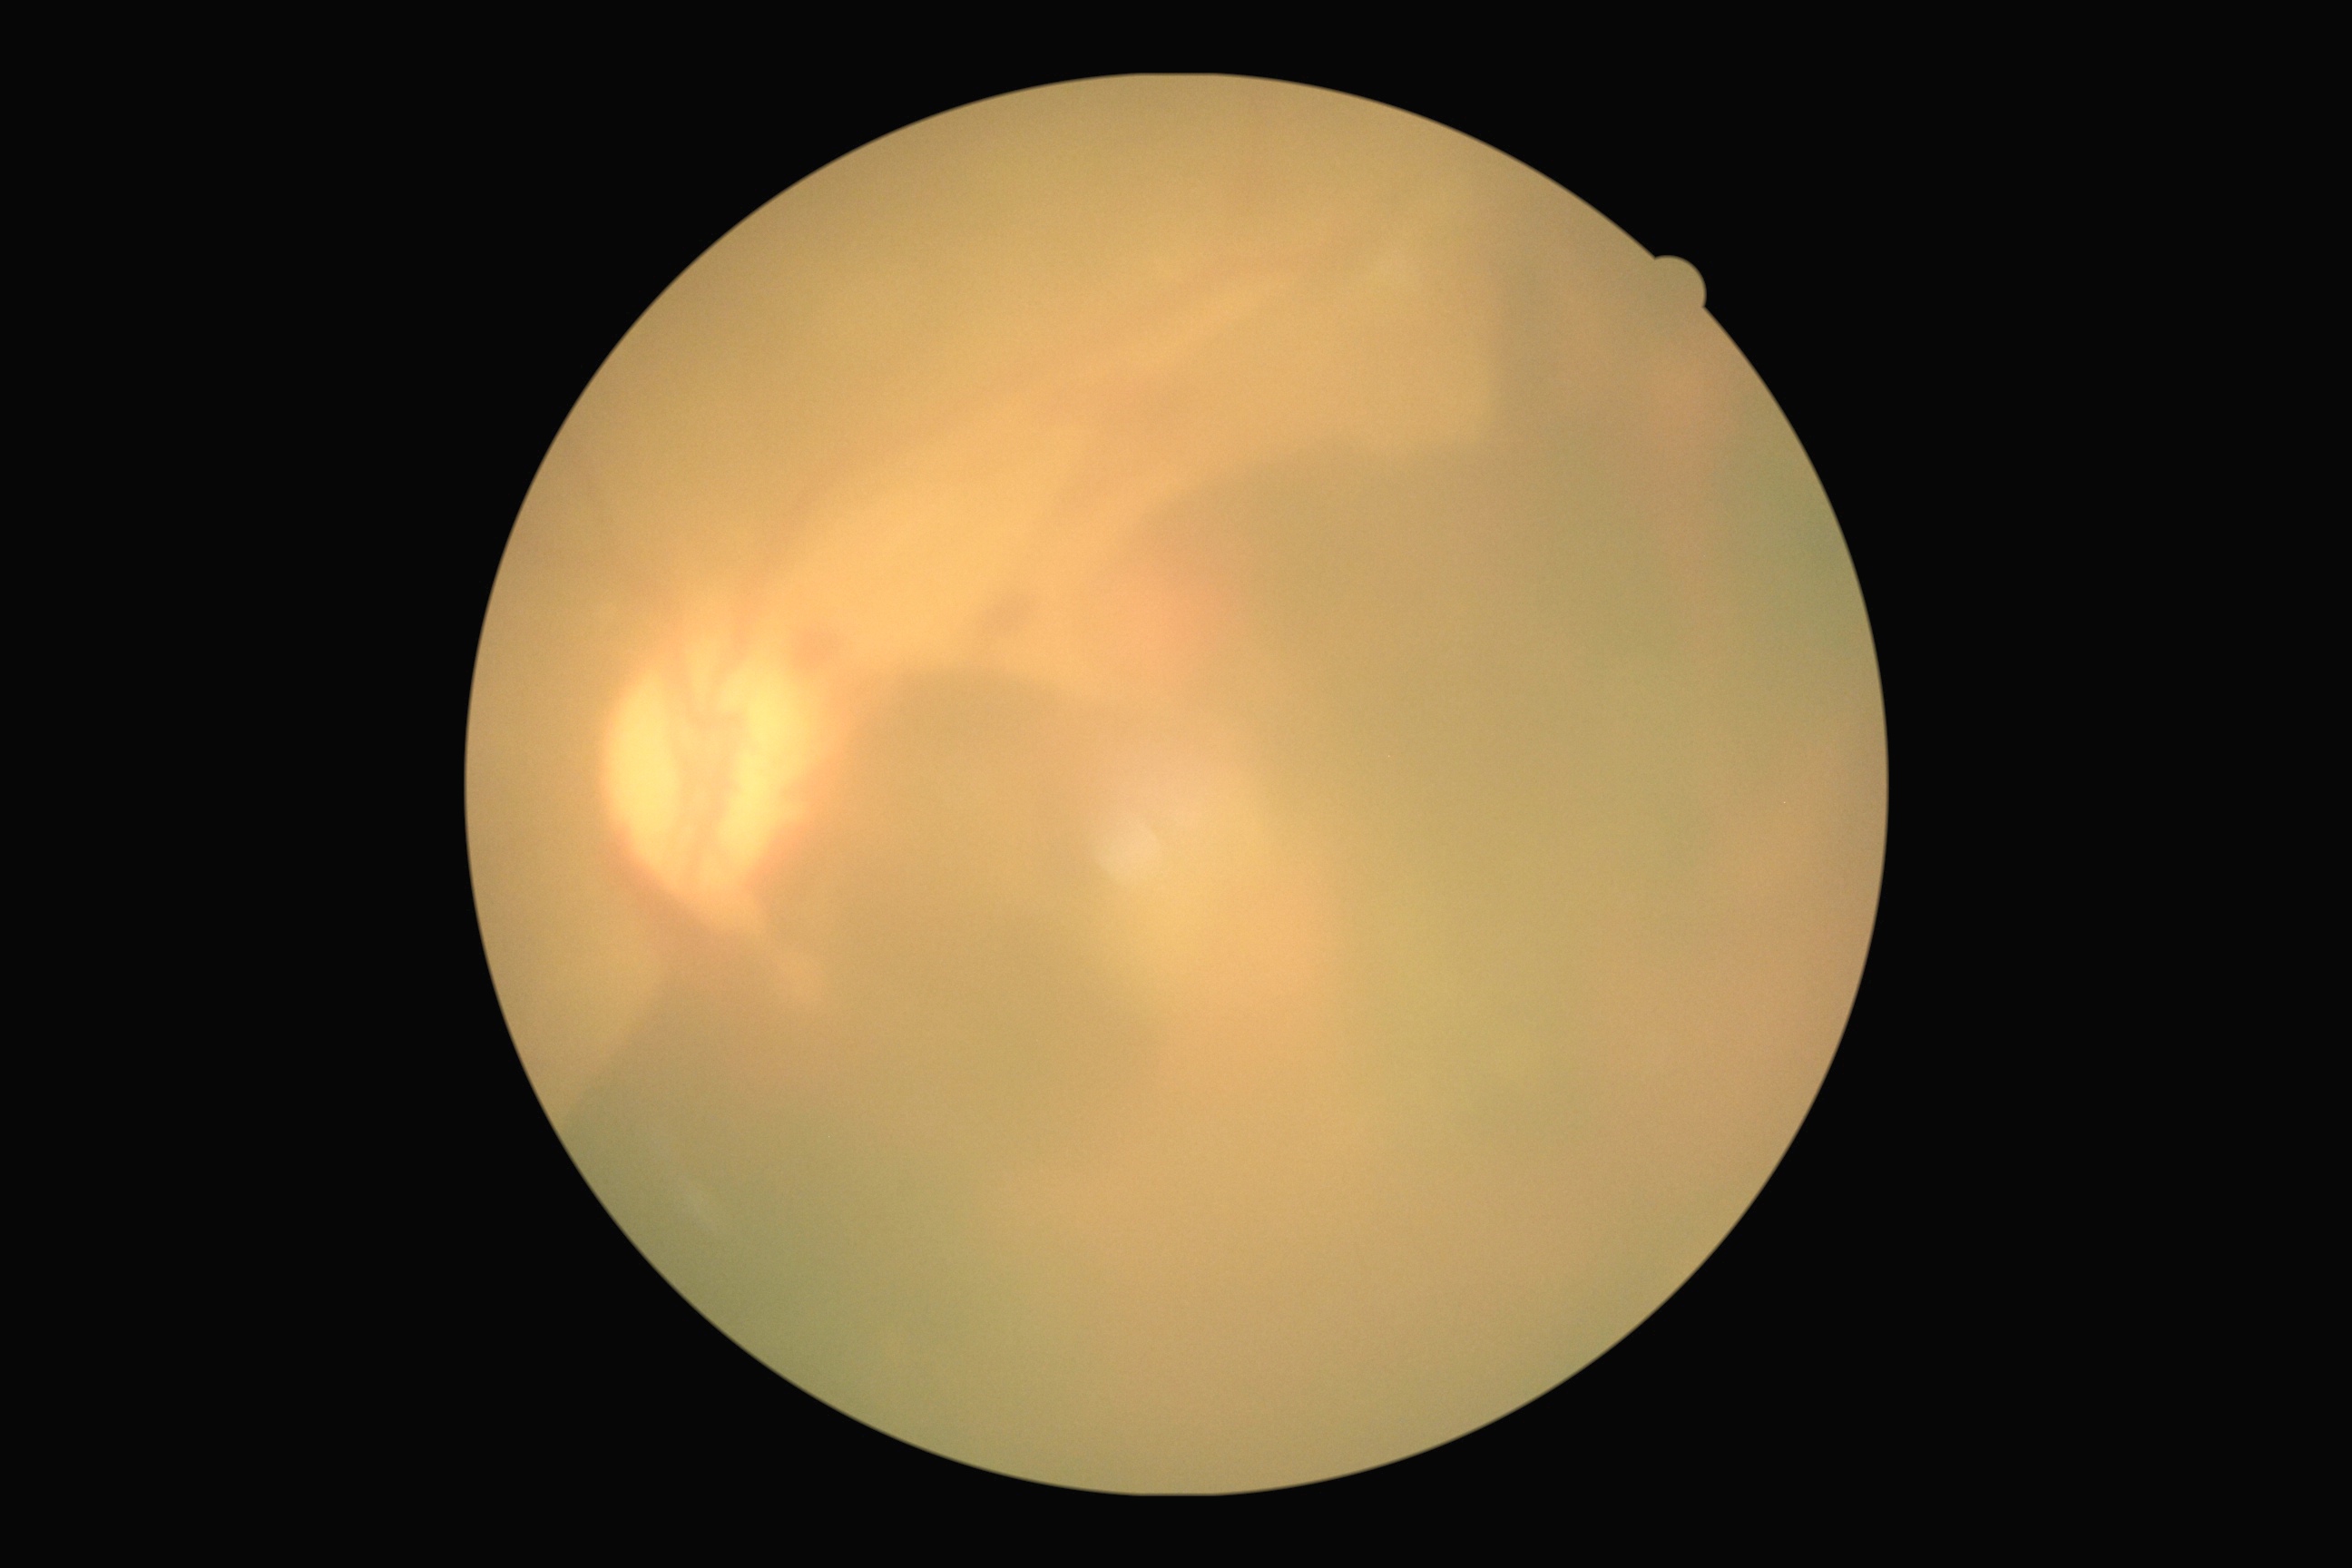
DR severity = grade 4 (PDR) — neovascularization and/or vitreous/pre-retinal hemorrhage.